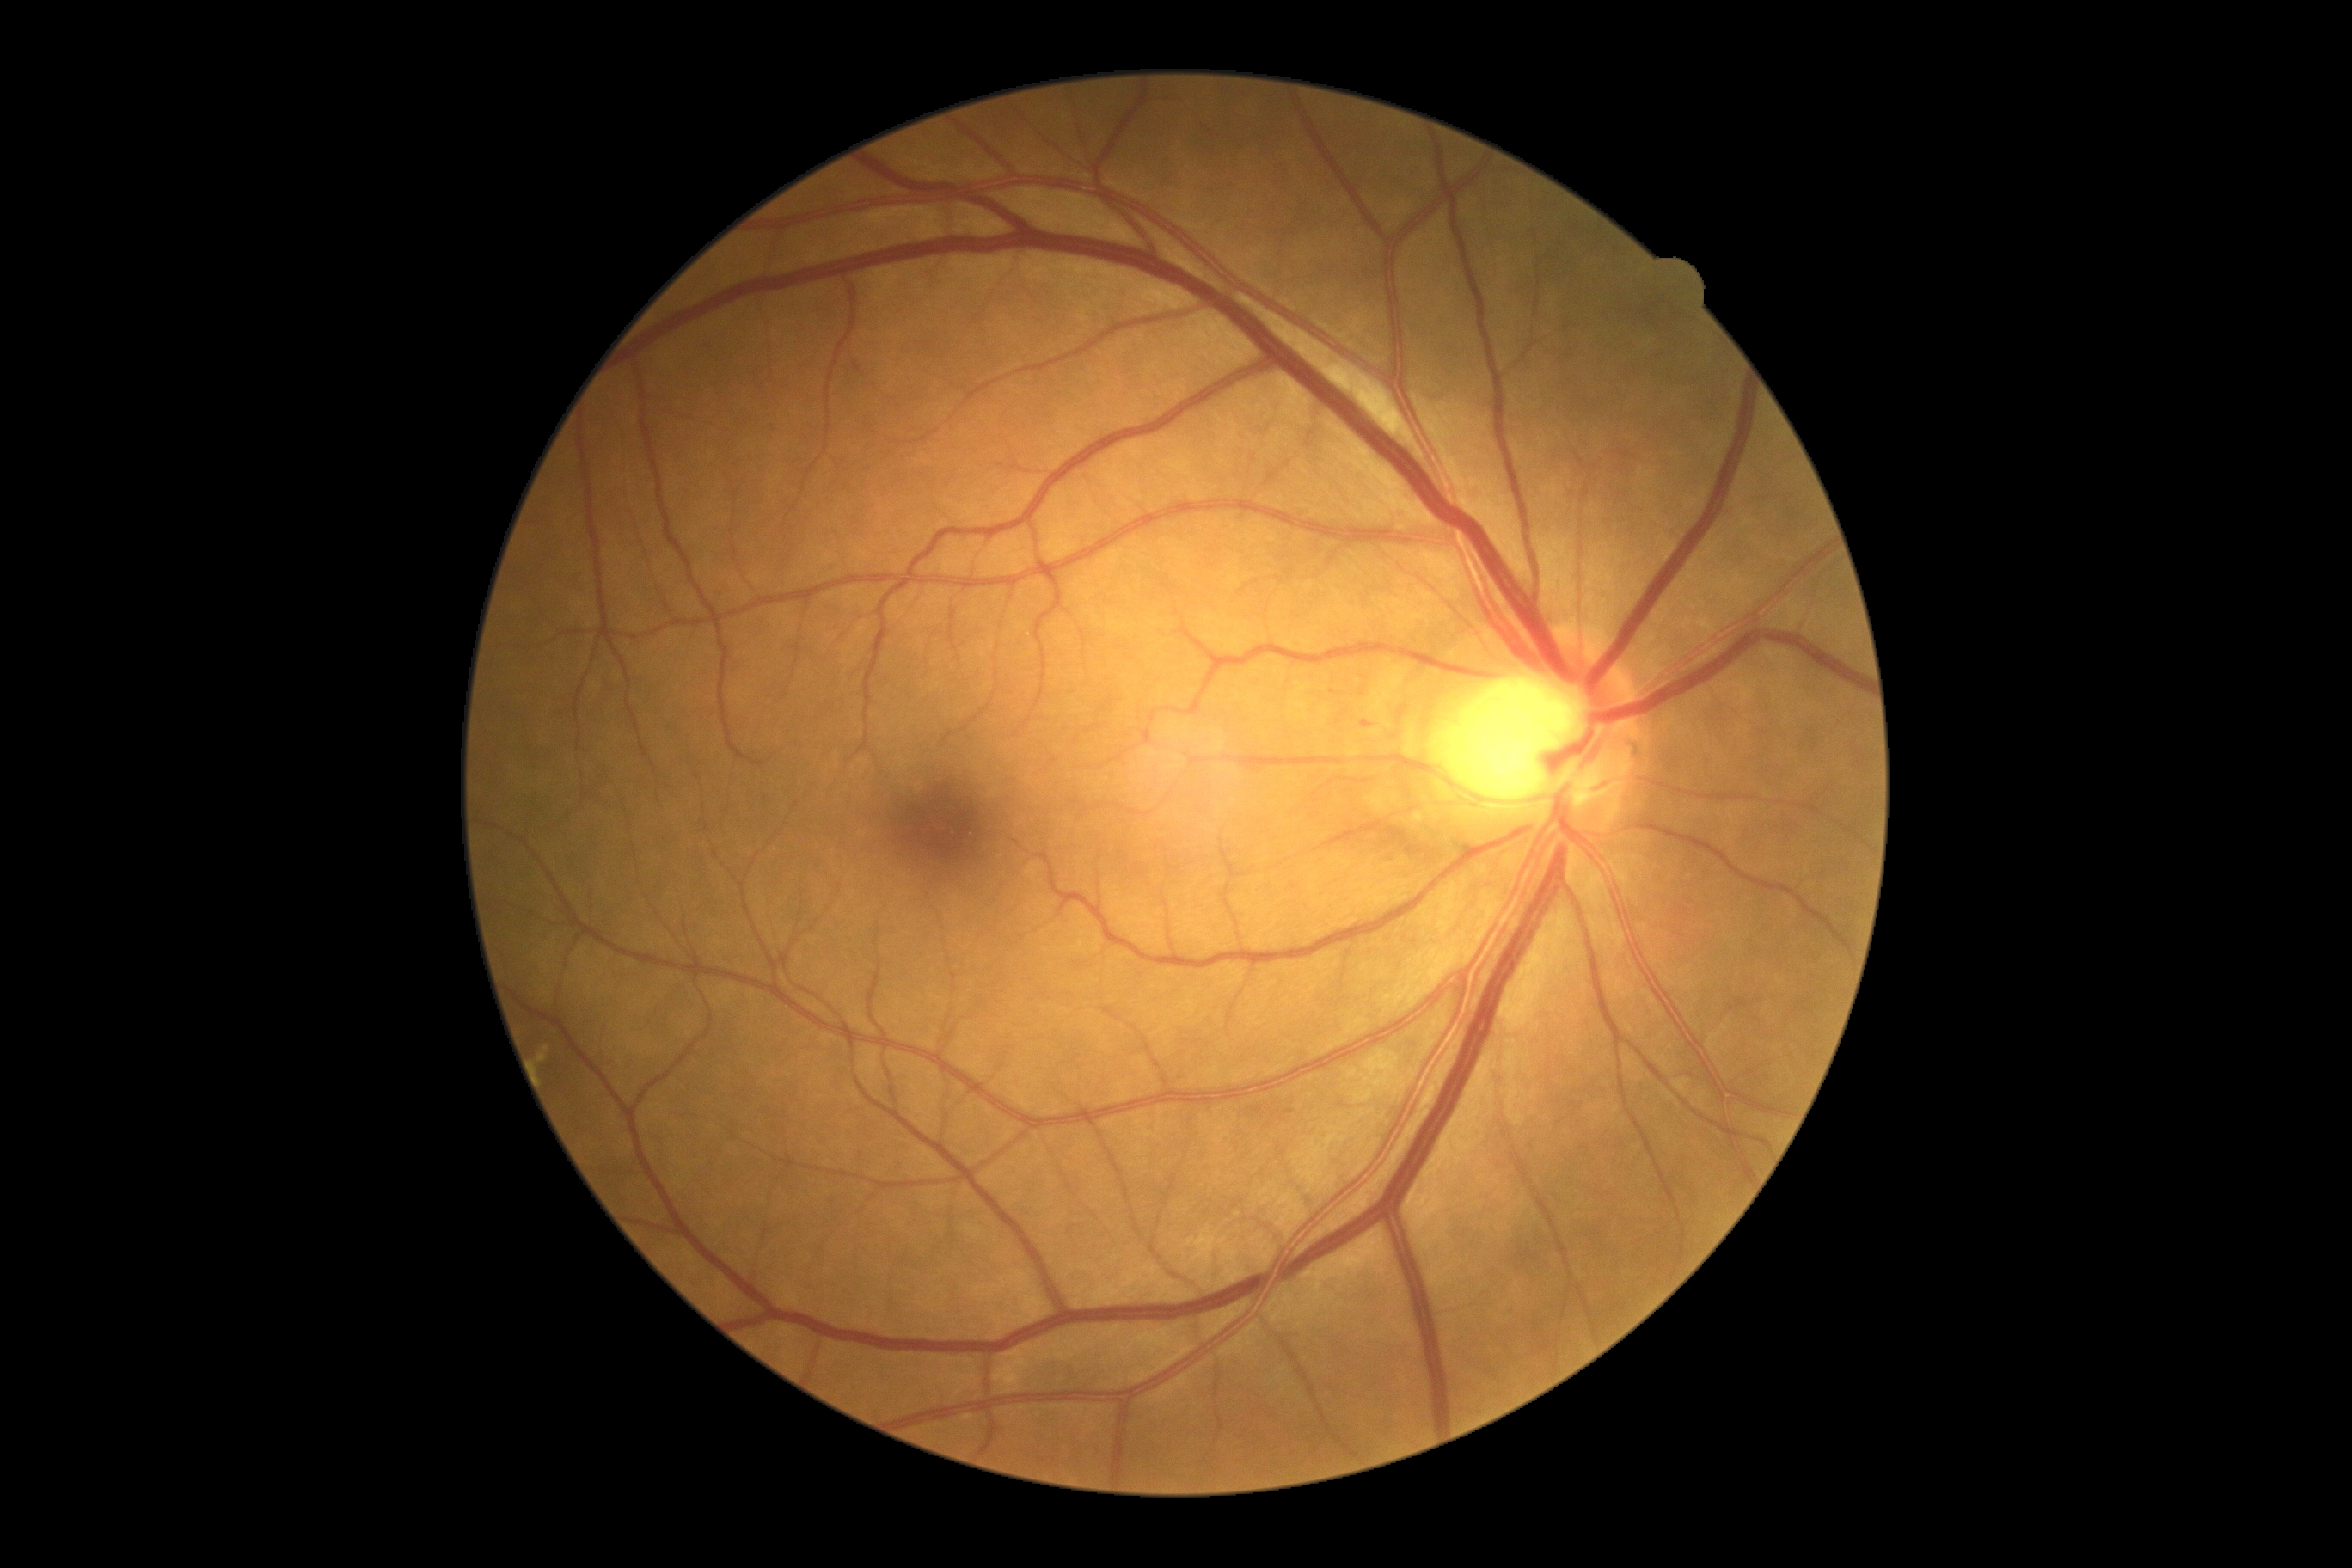

Diabetic retinopathy grade: 2/4.